Captured with the Clarity RetCam 3 (130° field of view). 640 by 480 pixels. Pediatric retinal photograph (wide-field) — 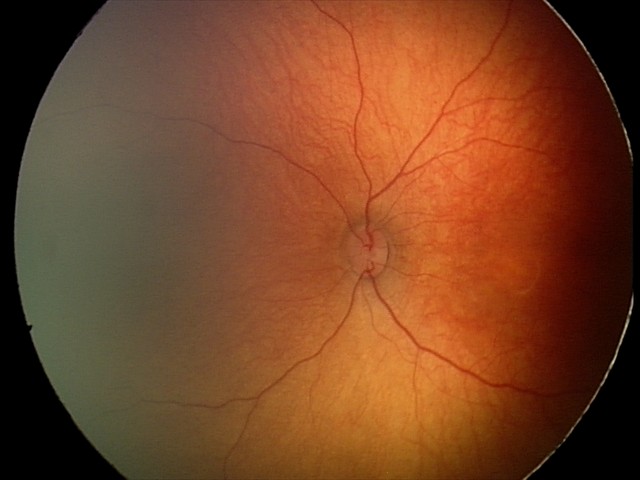
Physiological retinal appearance for postconceptual age.